45-degree field of view. Image size 2048x1536. Retinal fundus photograph
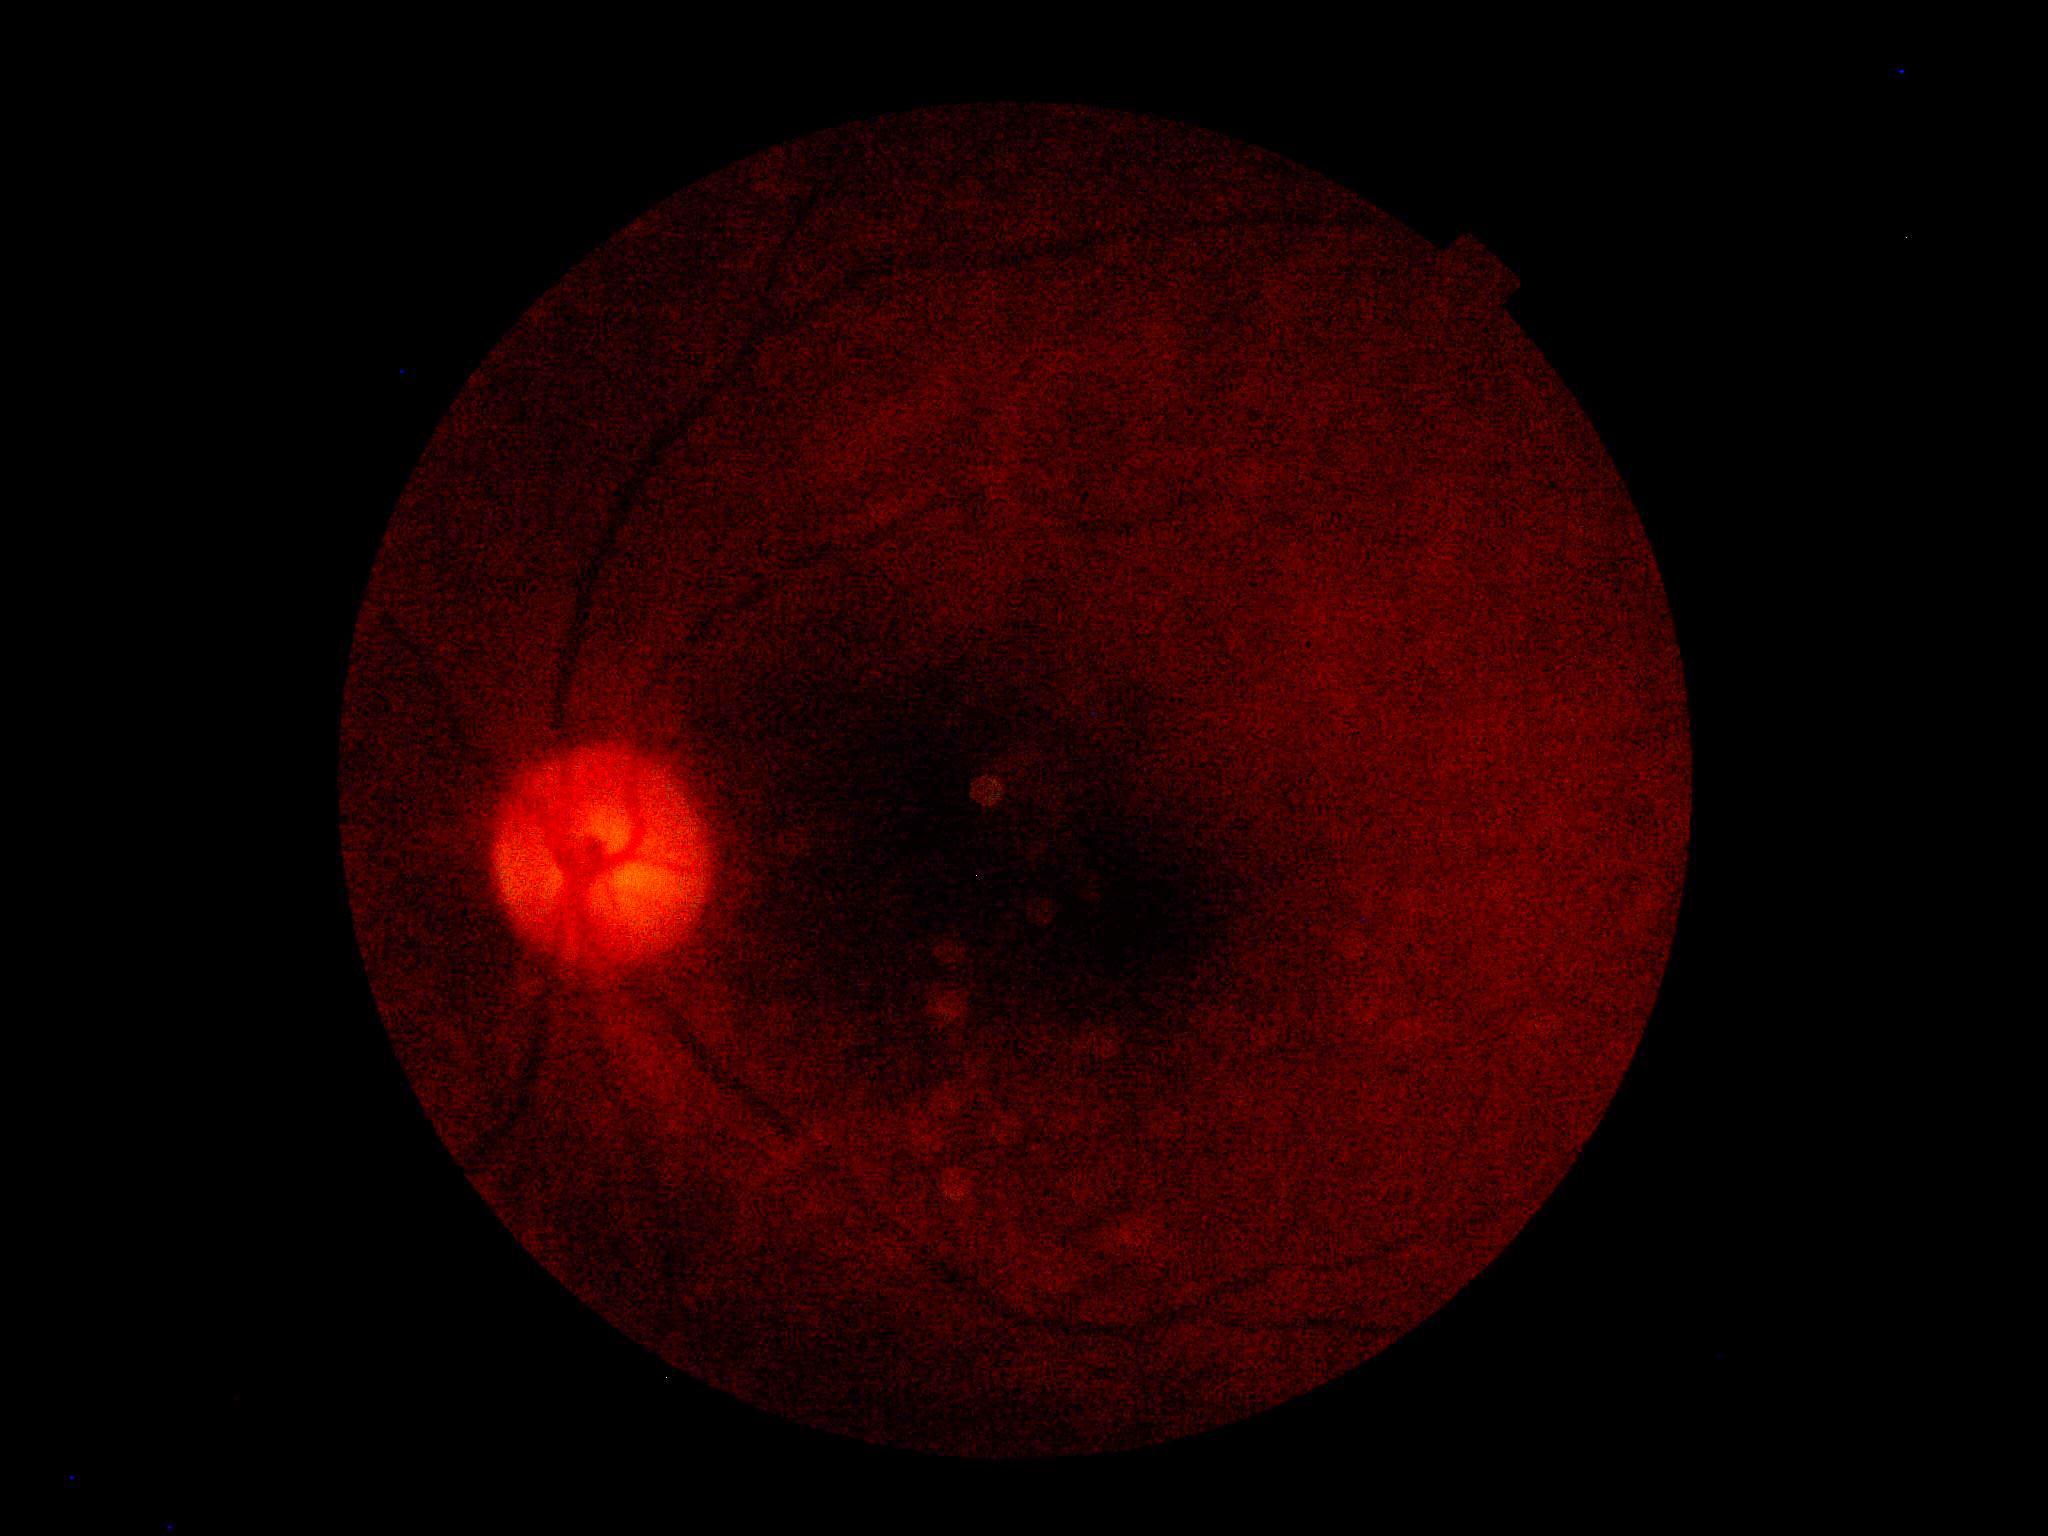 {"dr_grade": "ungradable"}